45° field of view: 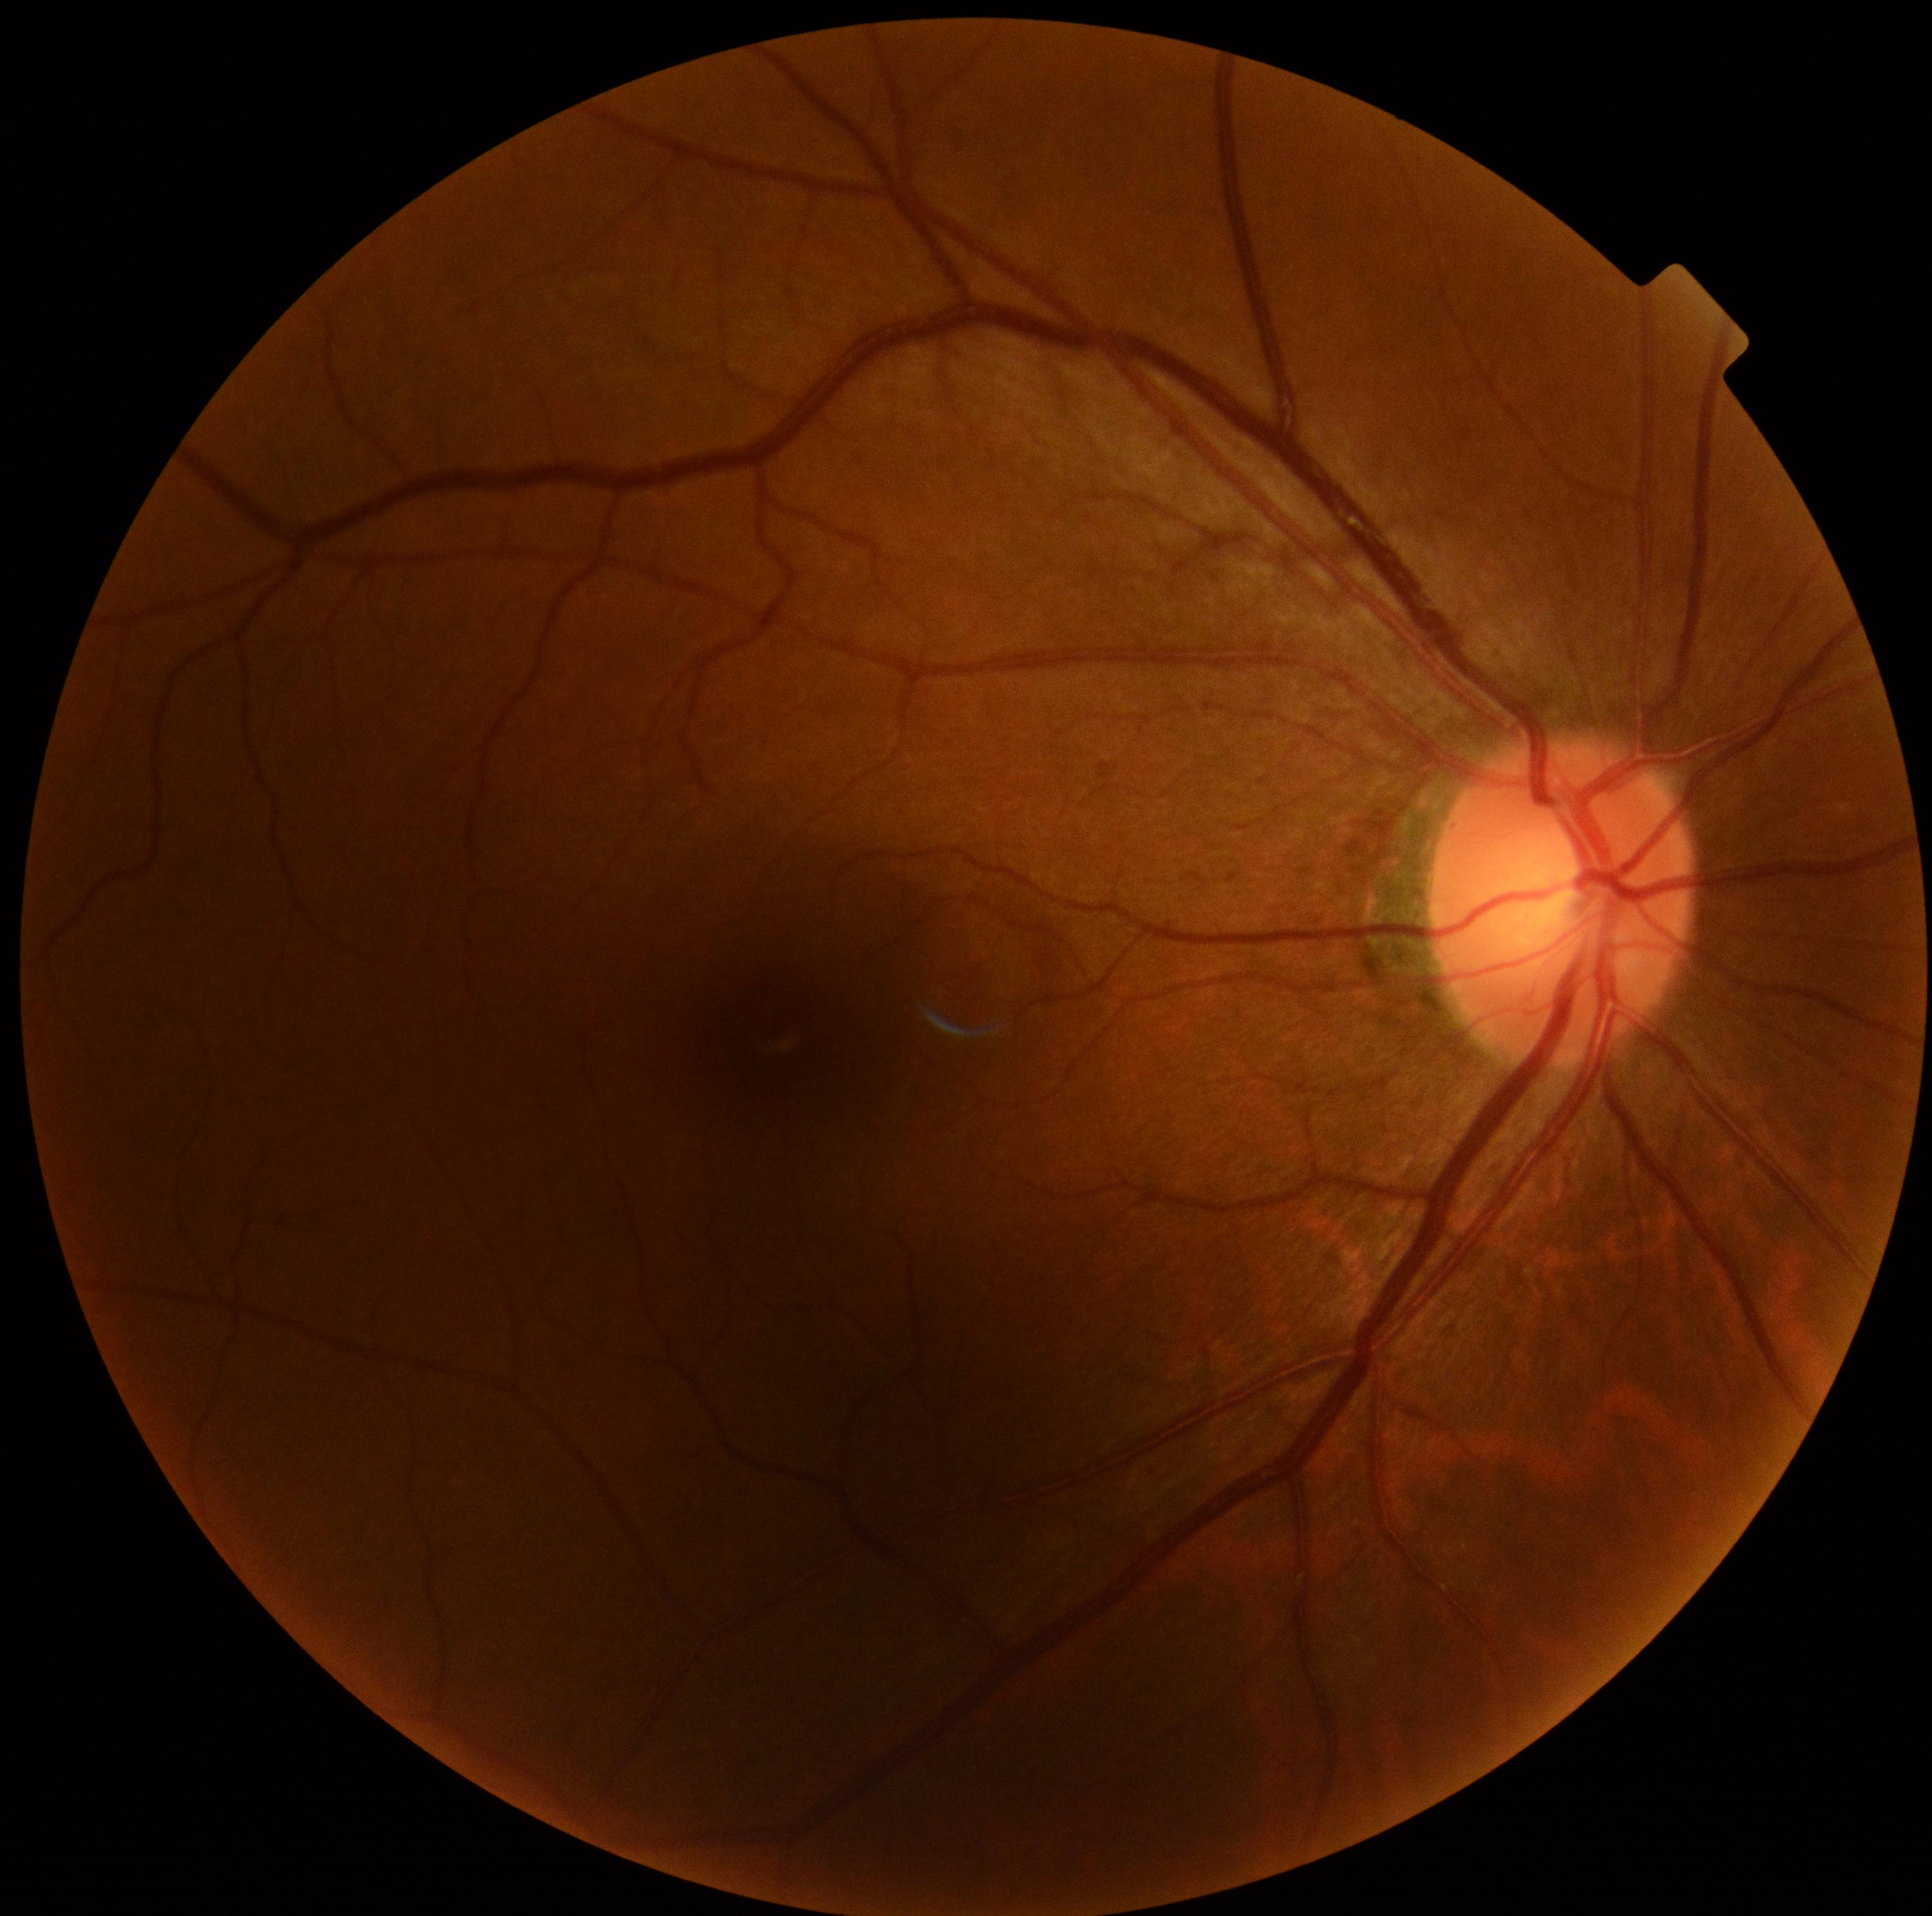 Diabetic retinopathy (DR) is 0/4.